1536 by 1152 pixels, color fundus photograph: 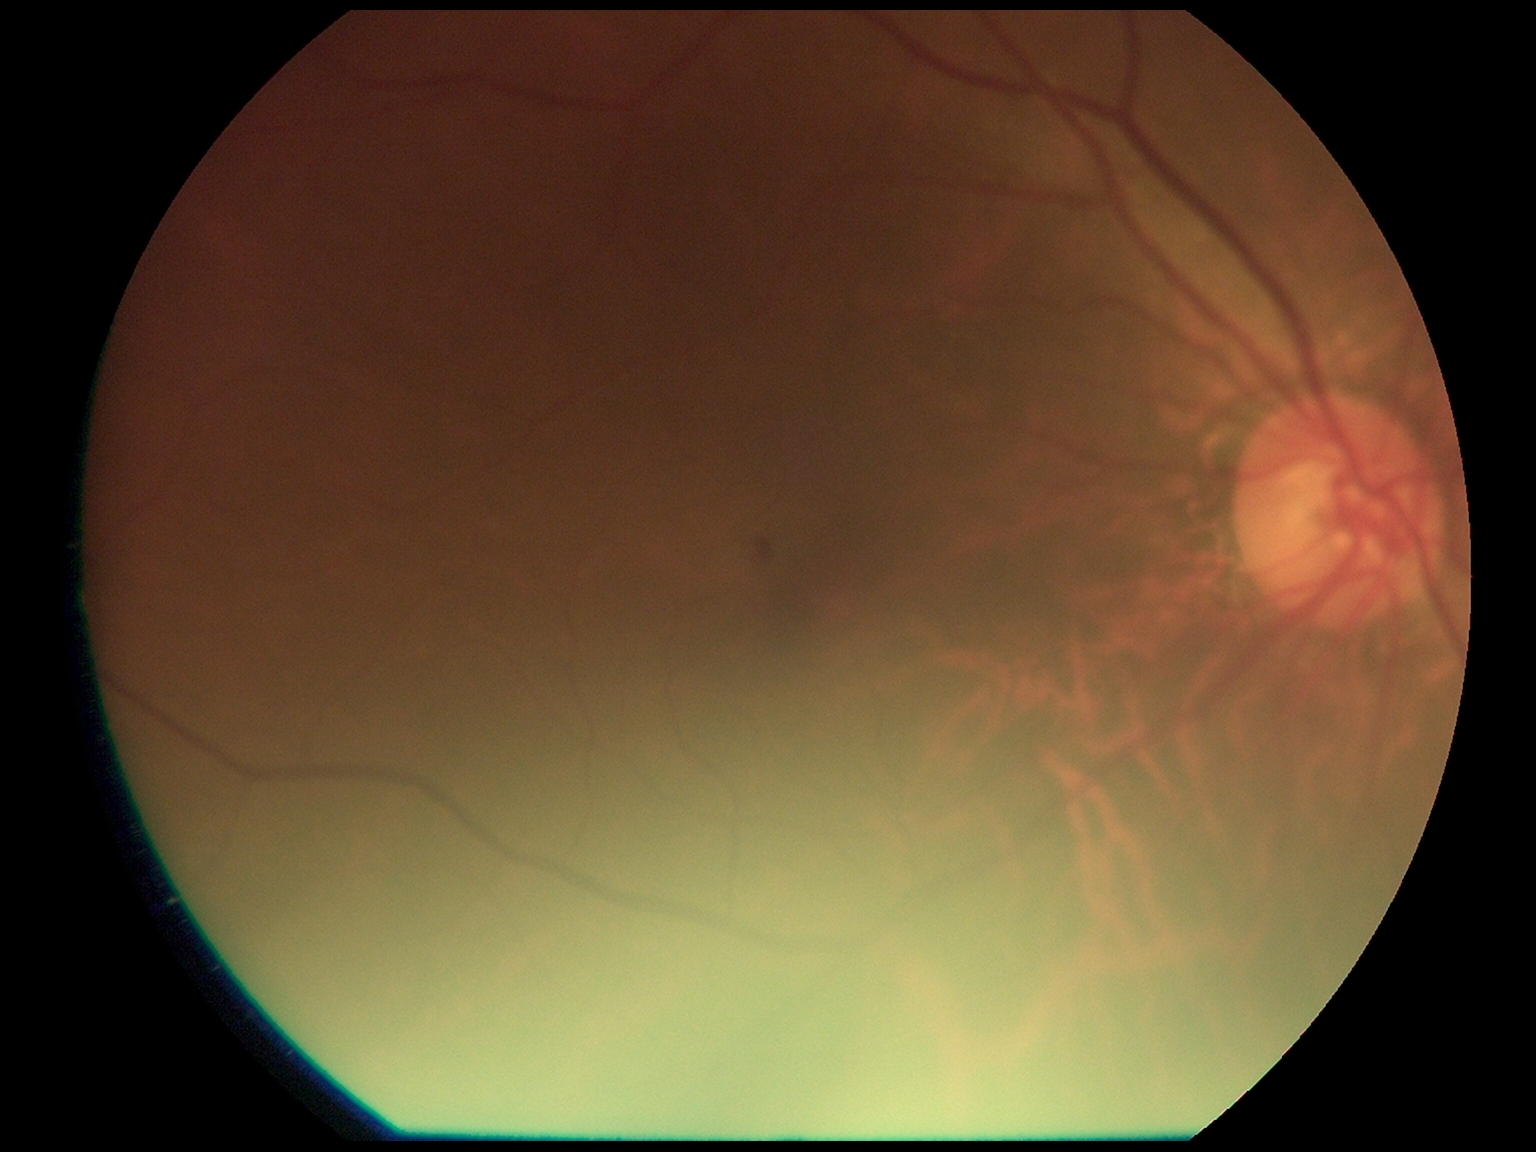 Diabetic retinopathy grade: moderate non-proliferative diabetic retinopathy (2).